Nonmydriatic · color fundus image · graded on the modified Davis scale · 848 by 848 pixels · FOV: 45 degrees — 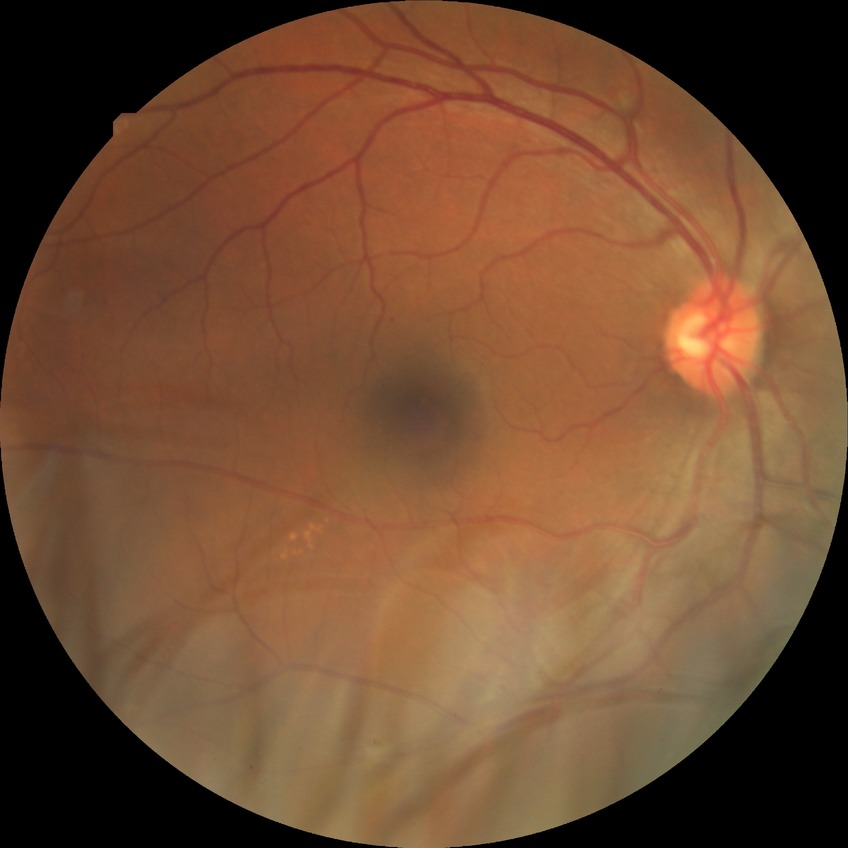

Diabetic retinopathy (DR) is simple diabetic retinopathy (SDR).